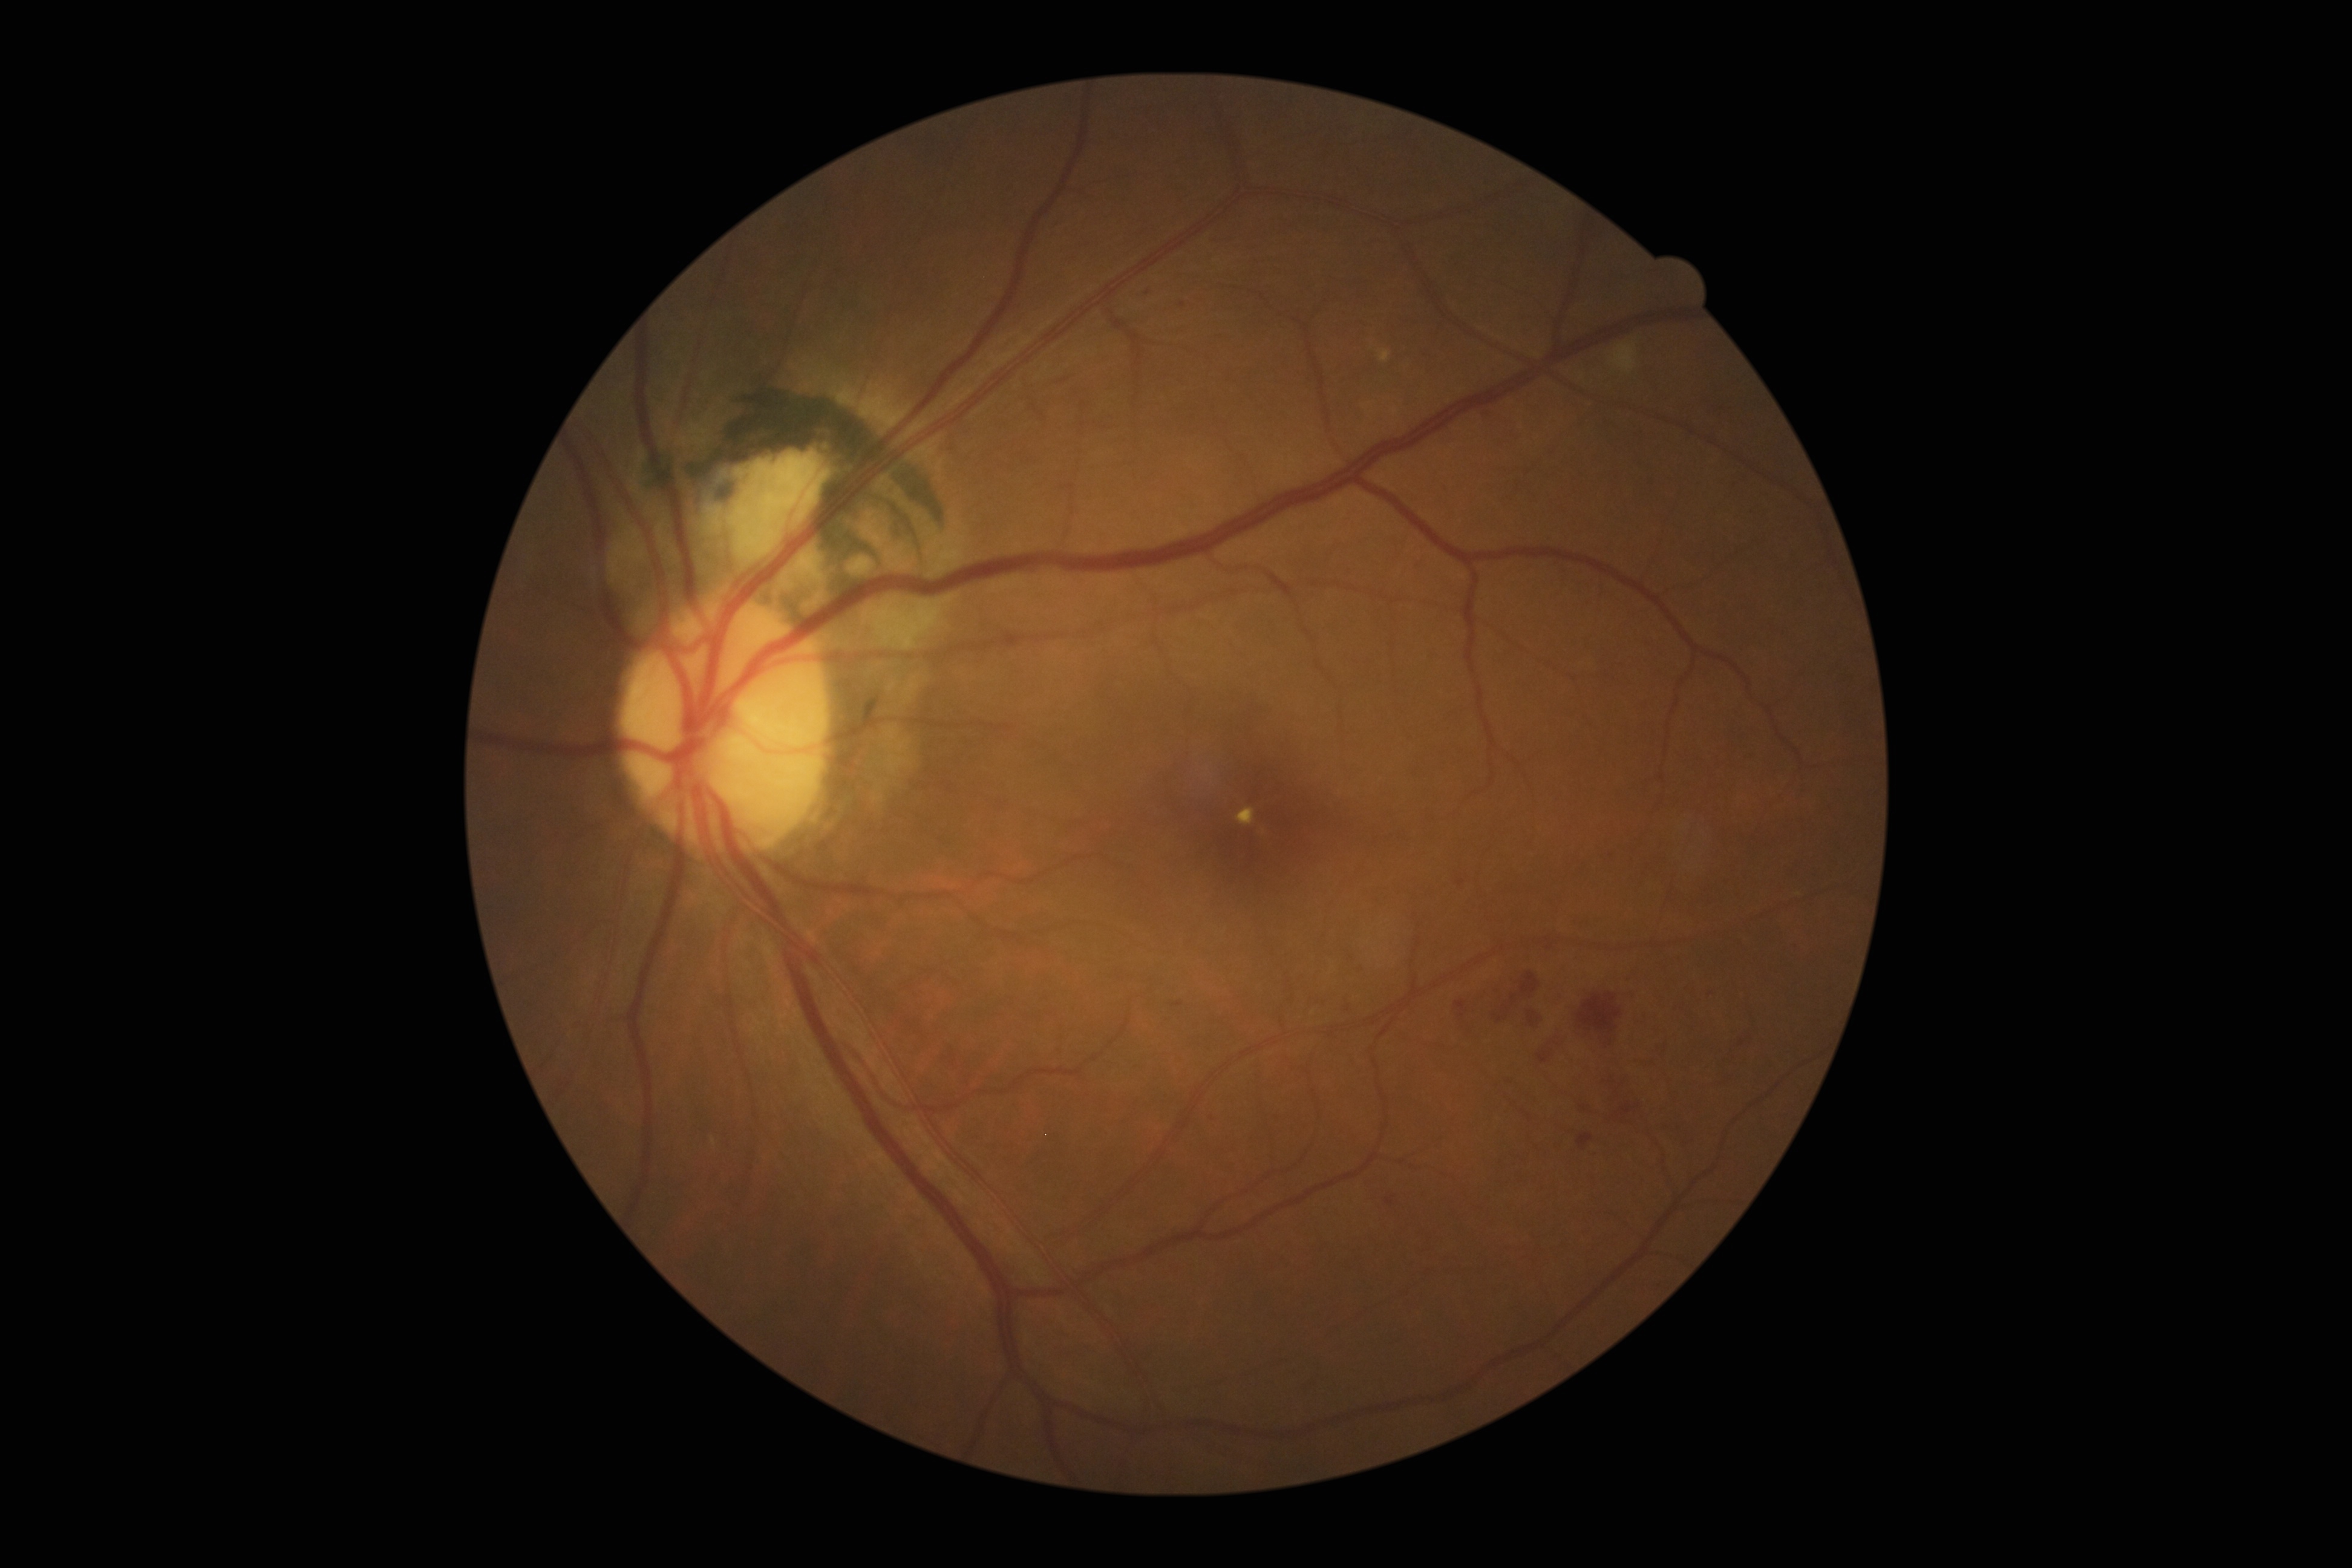 DR severity: moderate NPDR (grade 2); non-proliferative diabetic retinopathy.
MAs include BBox(1456, 880, 1466, 886); BBox(1455, 999, 1468, 1019); BBox(1511, 994, 1518, 1005); BBox(1494, 1013, 1506, 1022); BBox(1415, 561, 1426, 569).
Additional small MAs near (1498, 992); (1666, 1048); (1630, 979); (1654, 1062); (1148, 293); (1742, 1043); (1448, 493); (1182, 305).